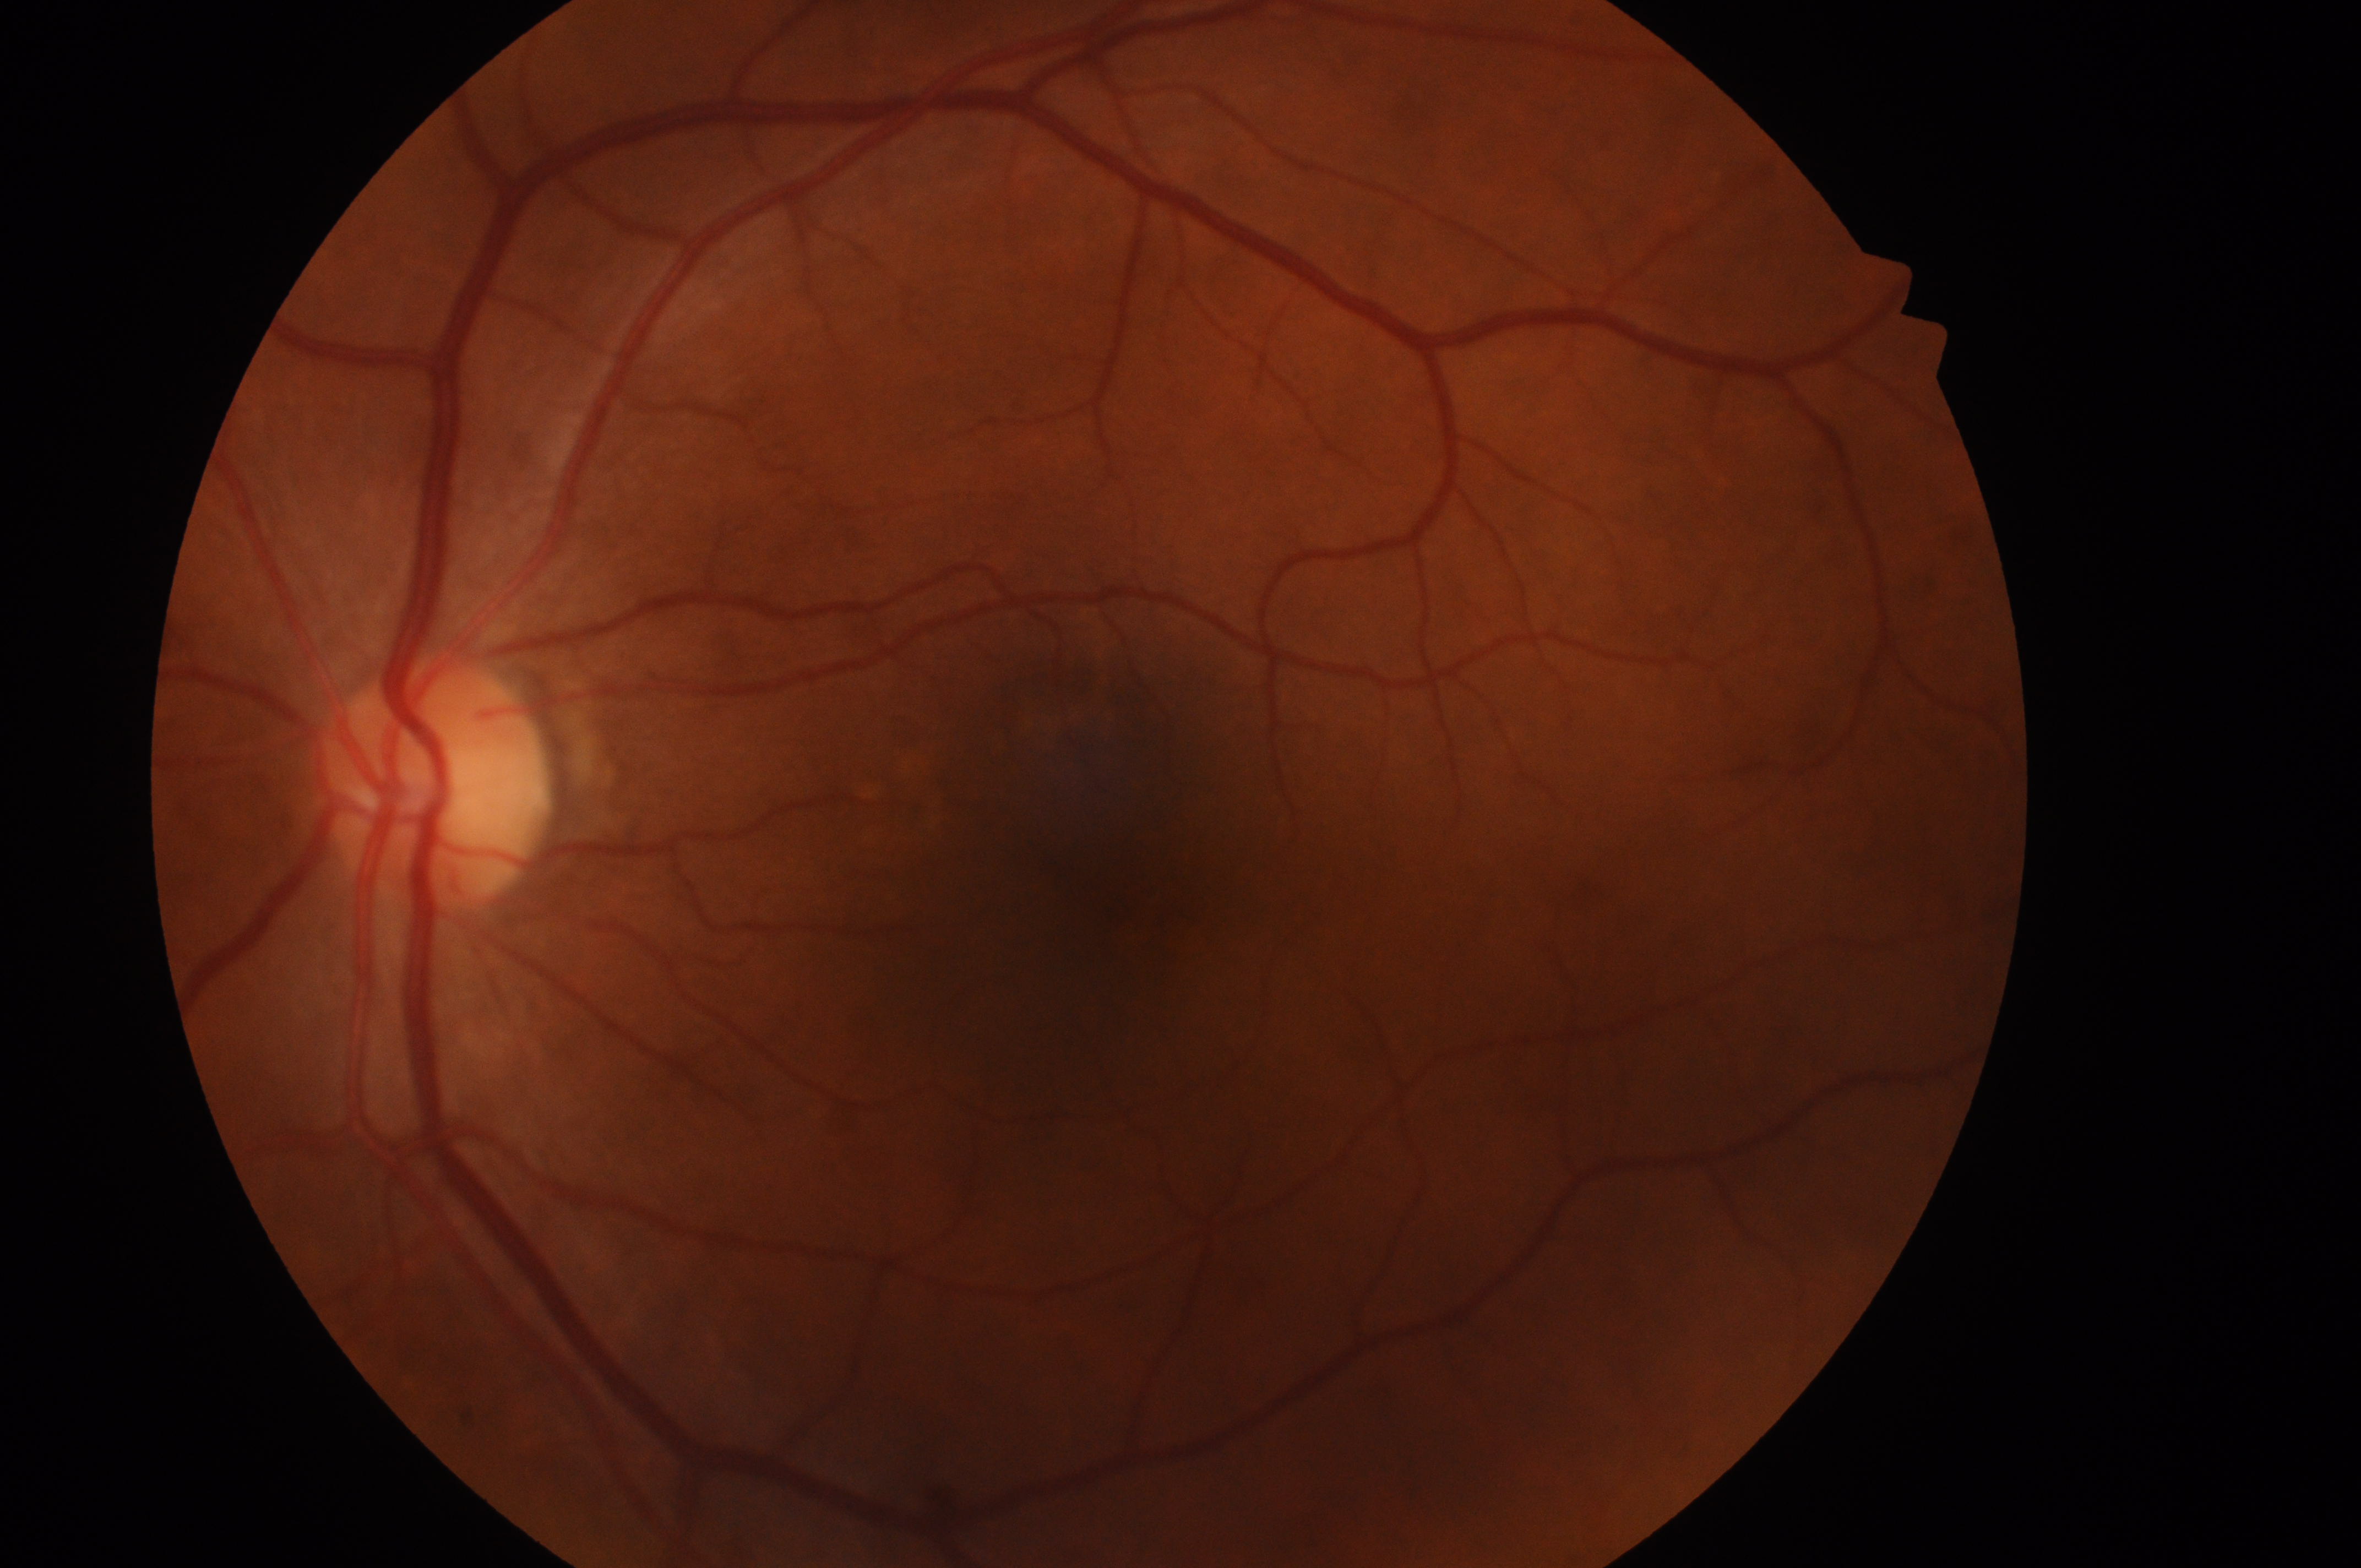

fovea centralis = 1147px, 889px | DR grade = no apparent diabetic retinopathy (0) | optic nerve head = 433px, 792px | DME = grade 0 (no risk) | laterality = the left eye.